Acquired with a Remidio Fundus on Phone (FOP) camera, 1659 x 2212 pixels — 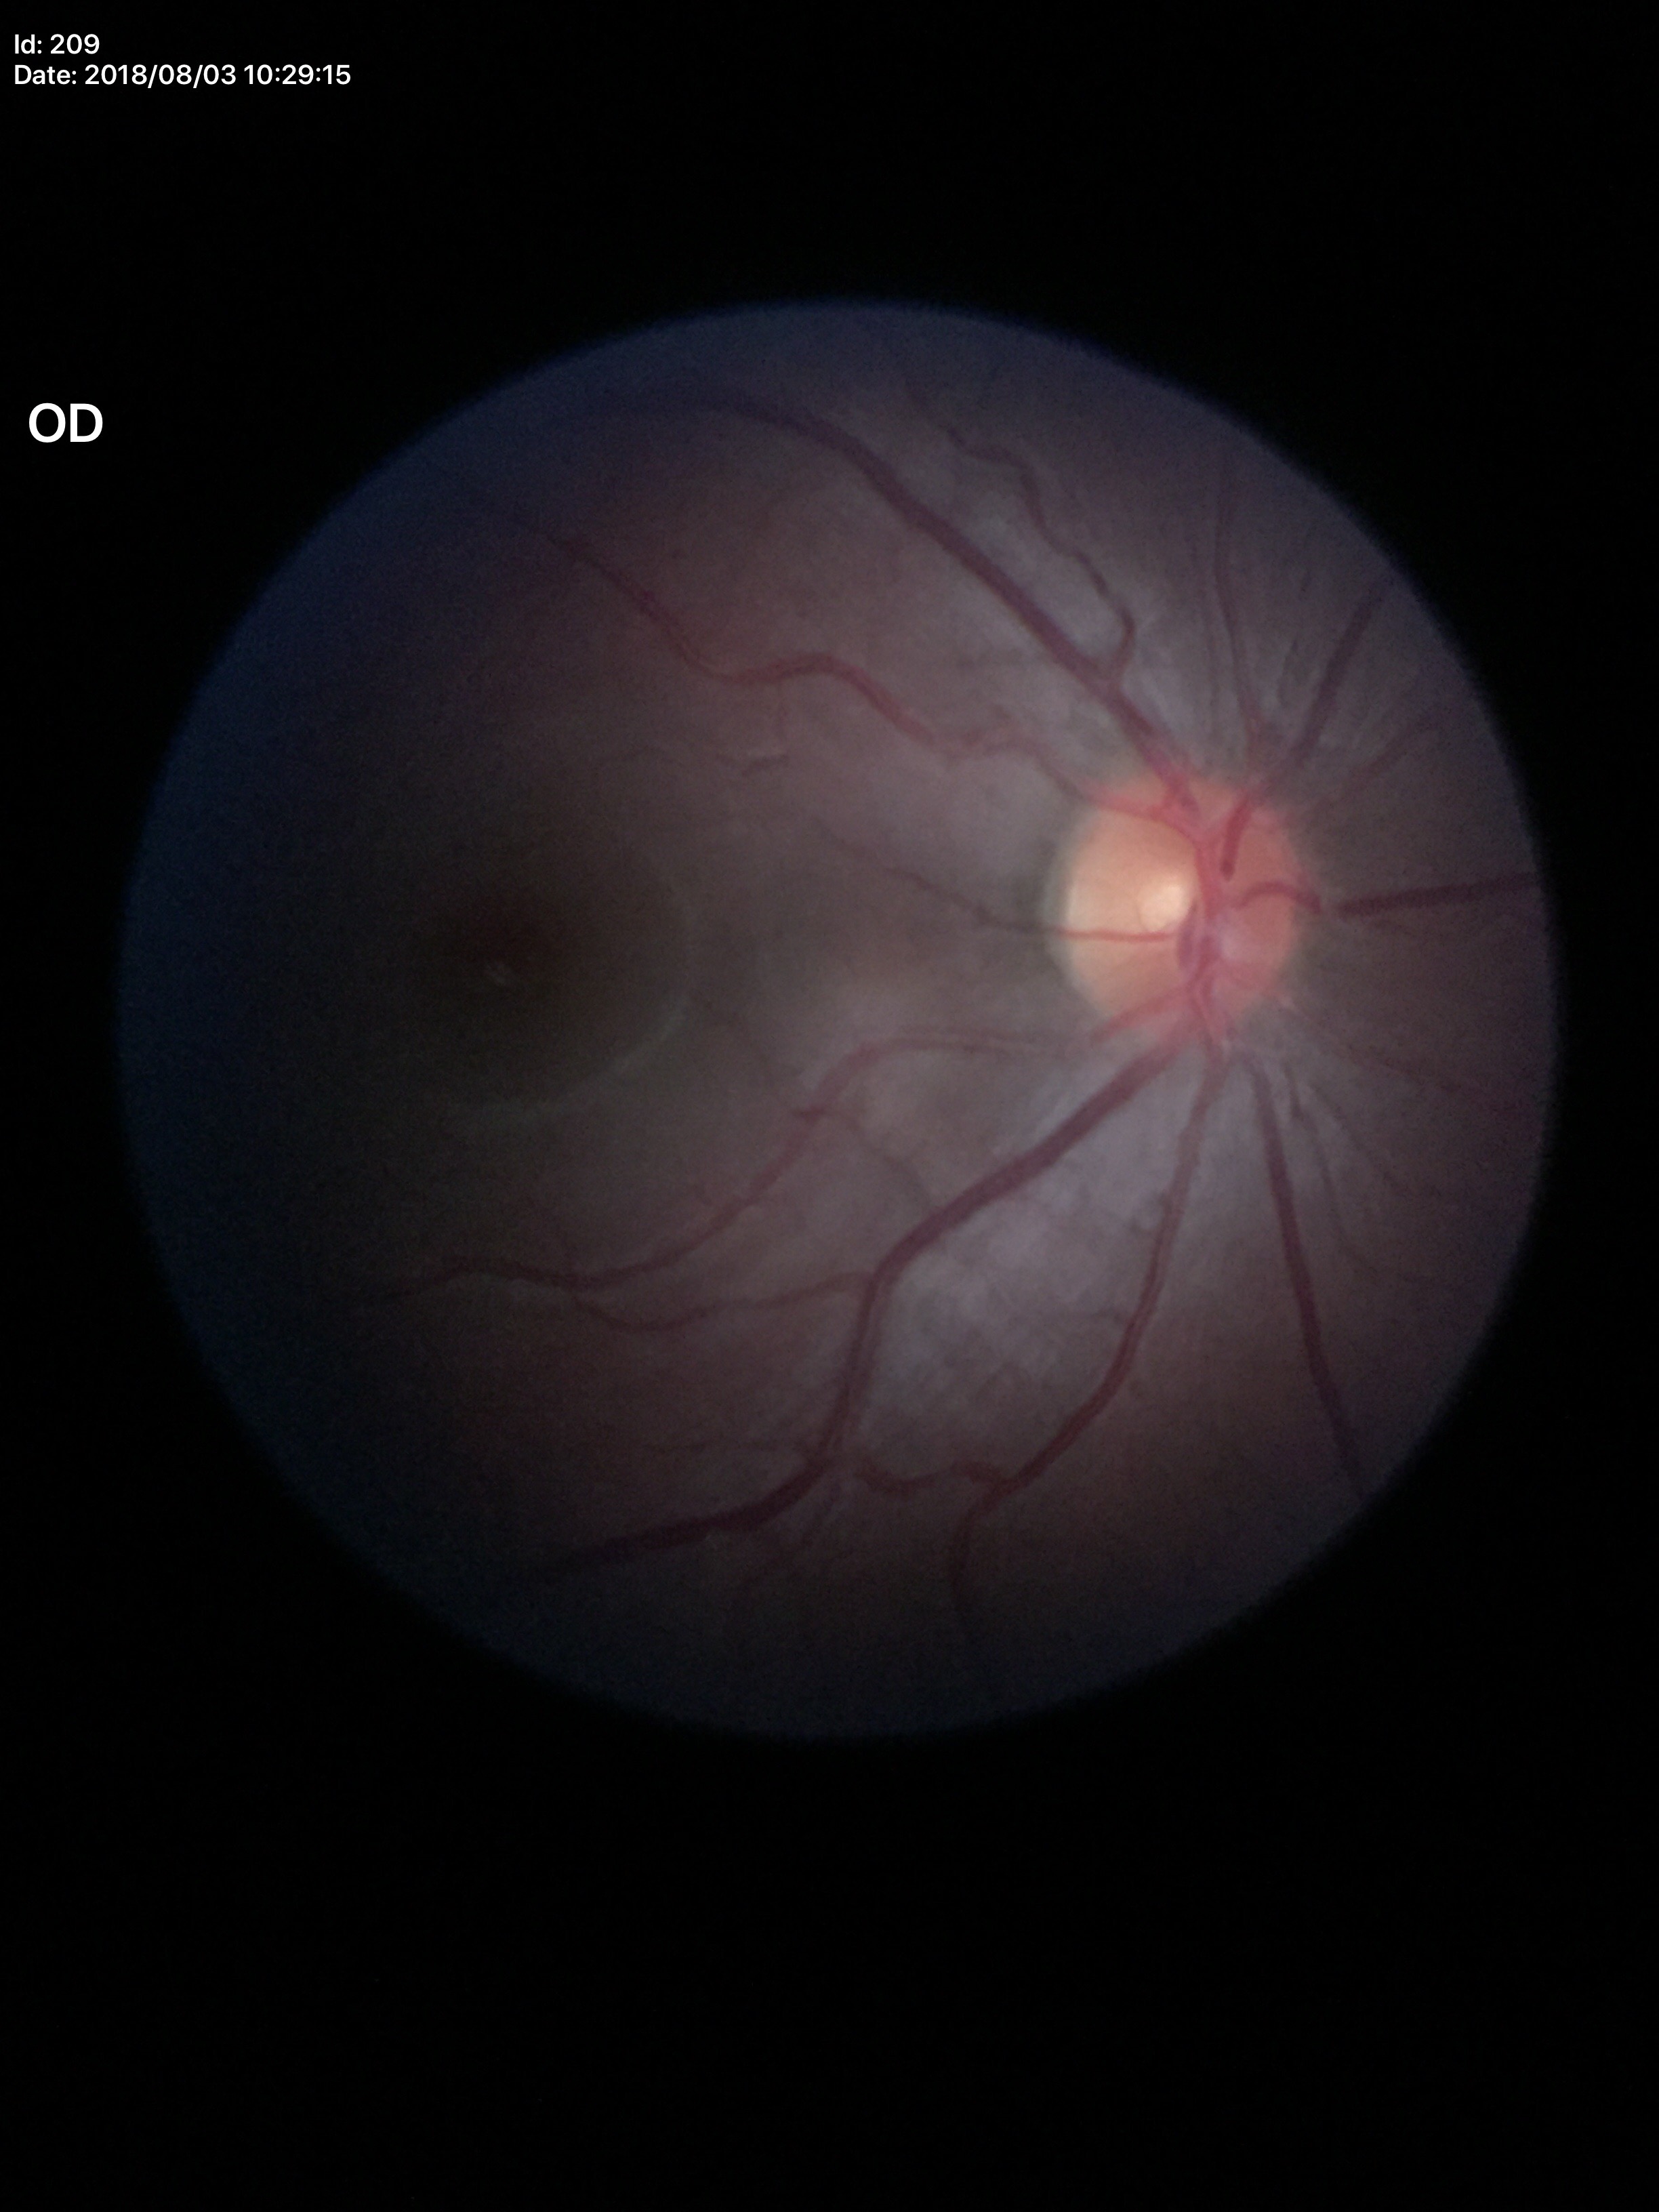

Glaucoma assessment: negative. Vertical CDR (VCDR): 0.28. Area cup-disc ratio (ACDR) of 0.10.